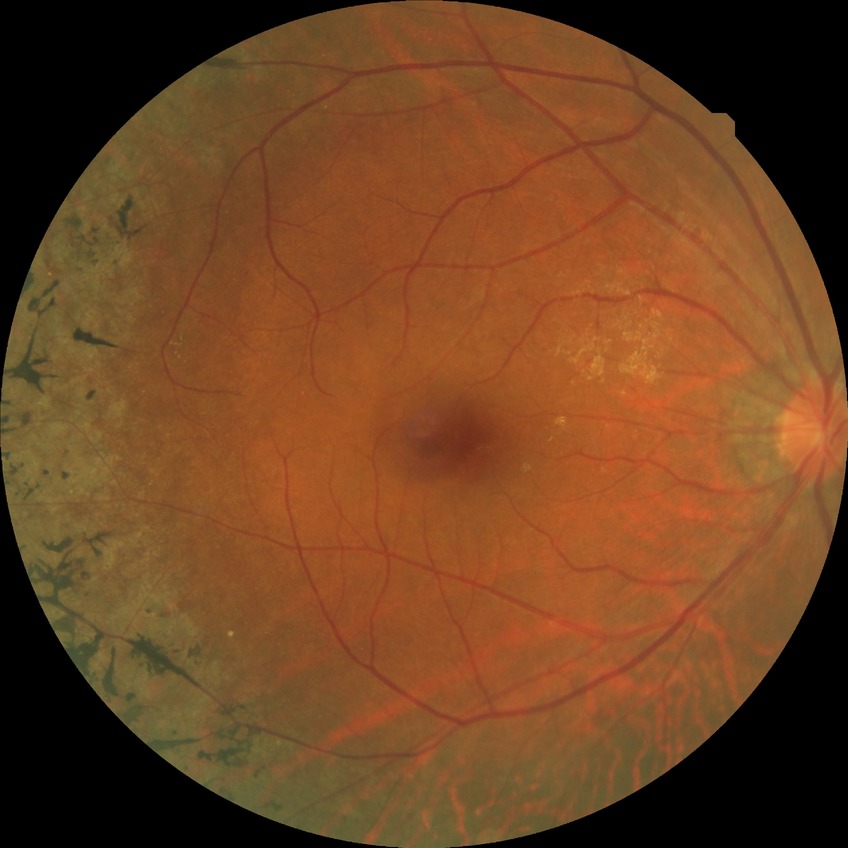

diabetic retinopathy (DR): NDR (no diabetic retinopathy).